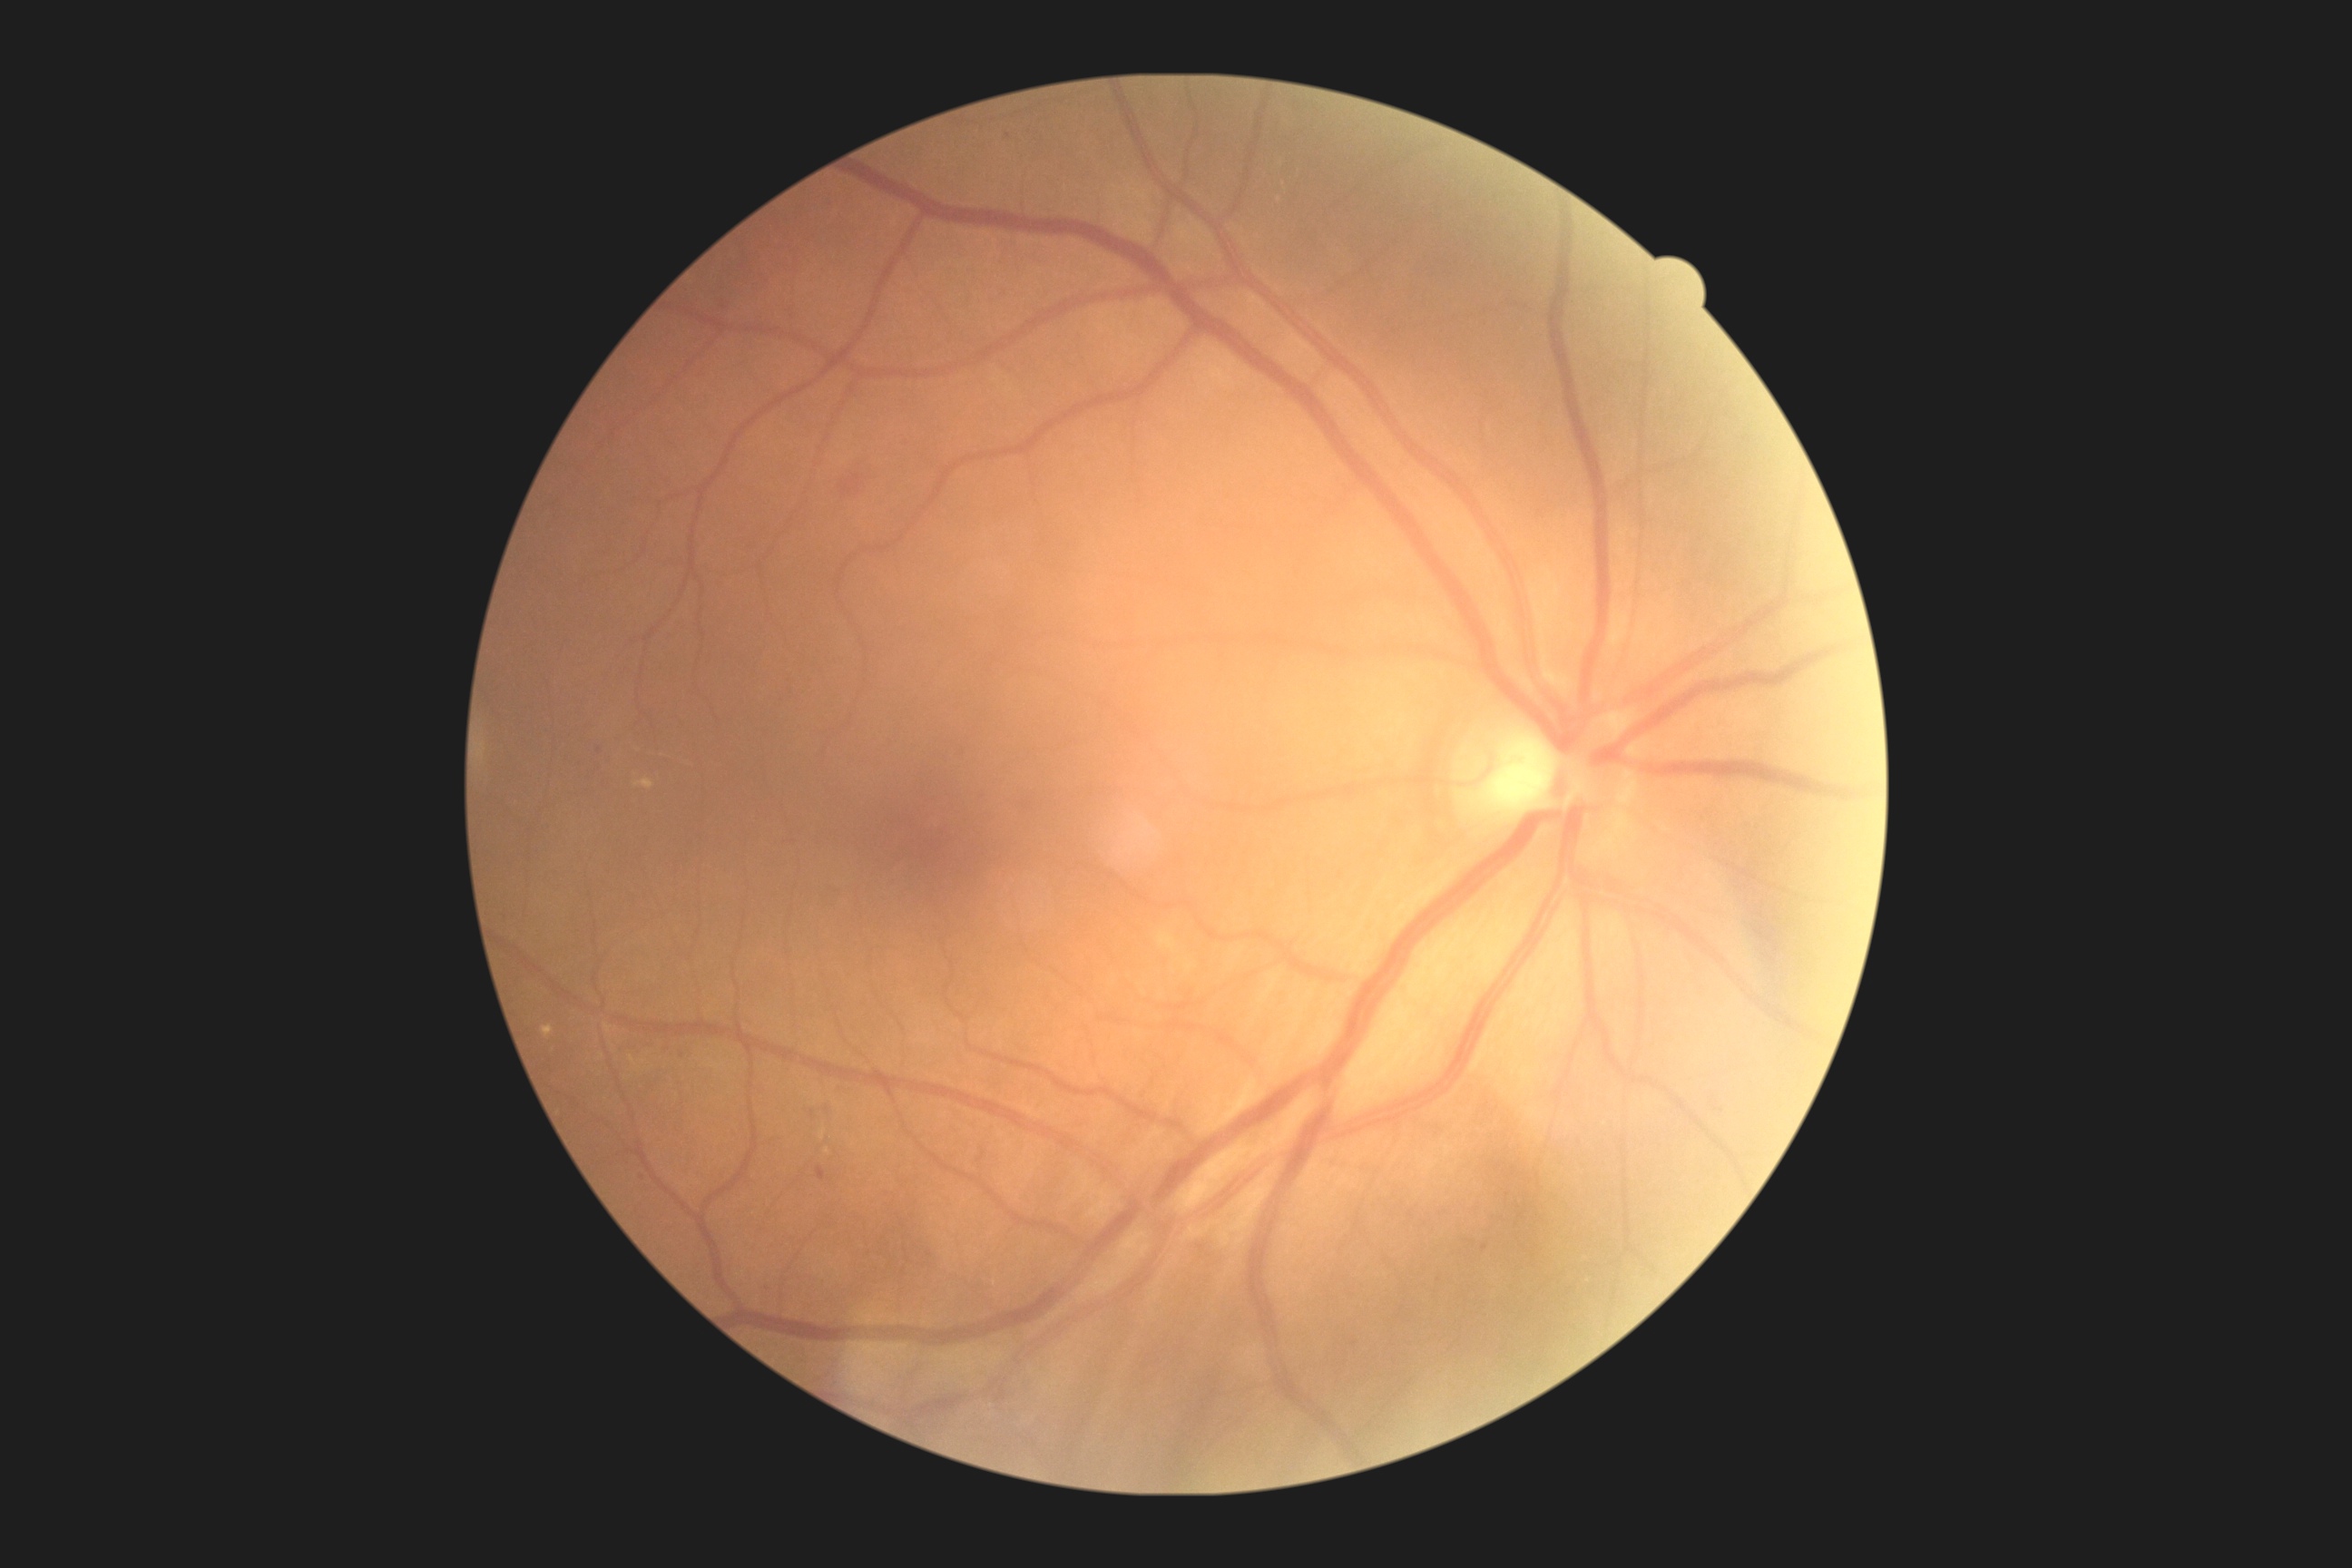 Retinopathy grade is 2 — more than just microaneurysms but less than severe NPDR.